Retinal fundus photograph: 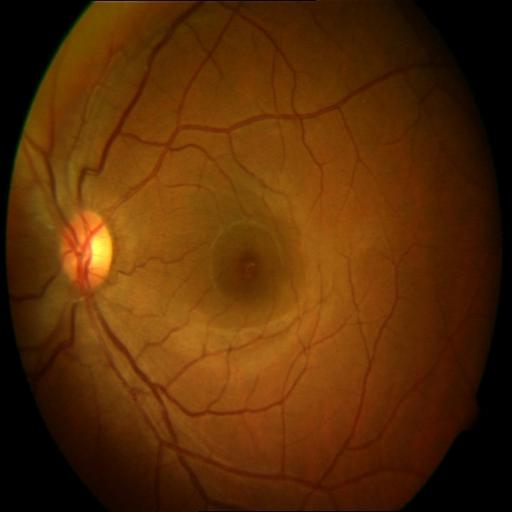
Abnormalities: central serous retinopathy.